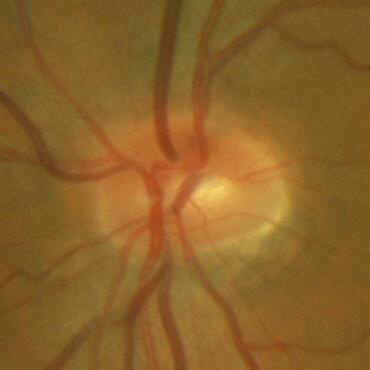
Impression: no glaucomatous changes.